50° field of view:
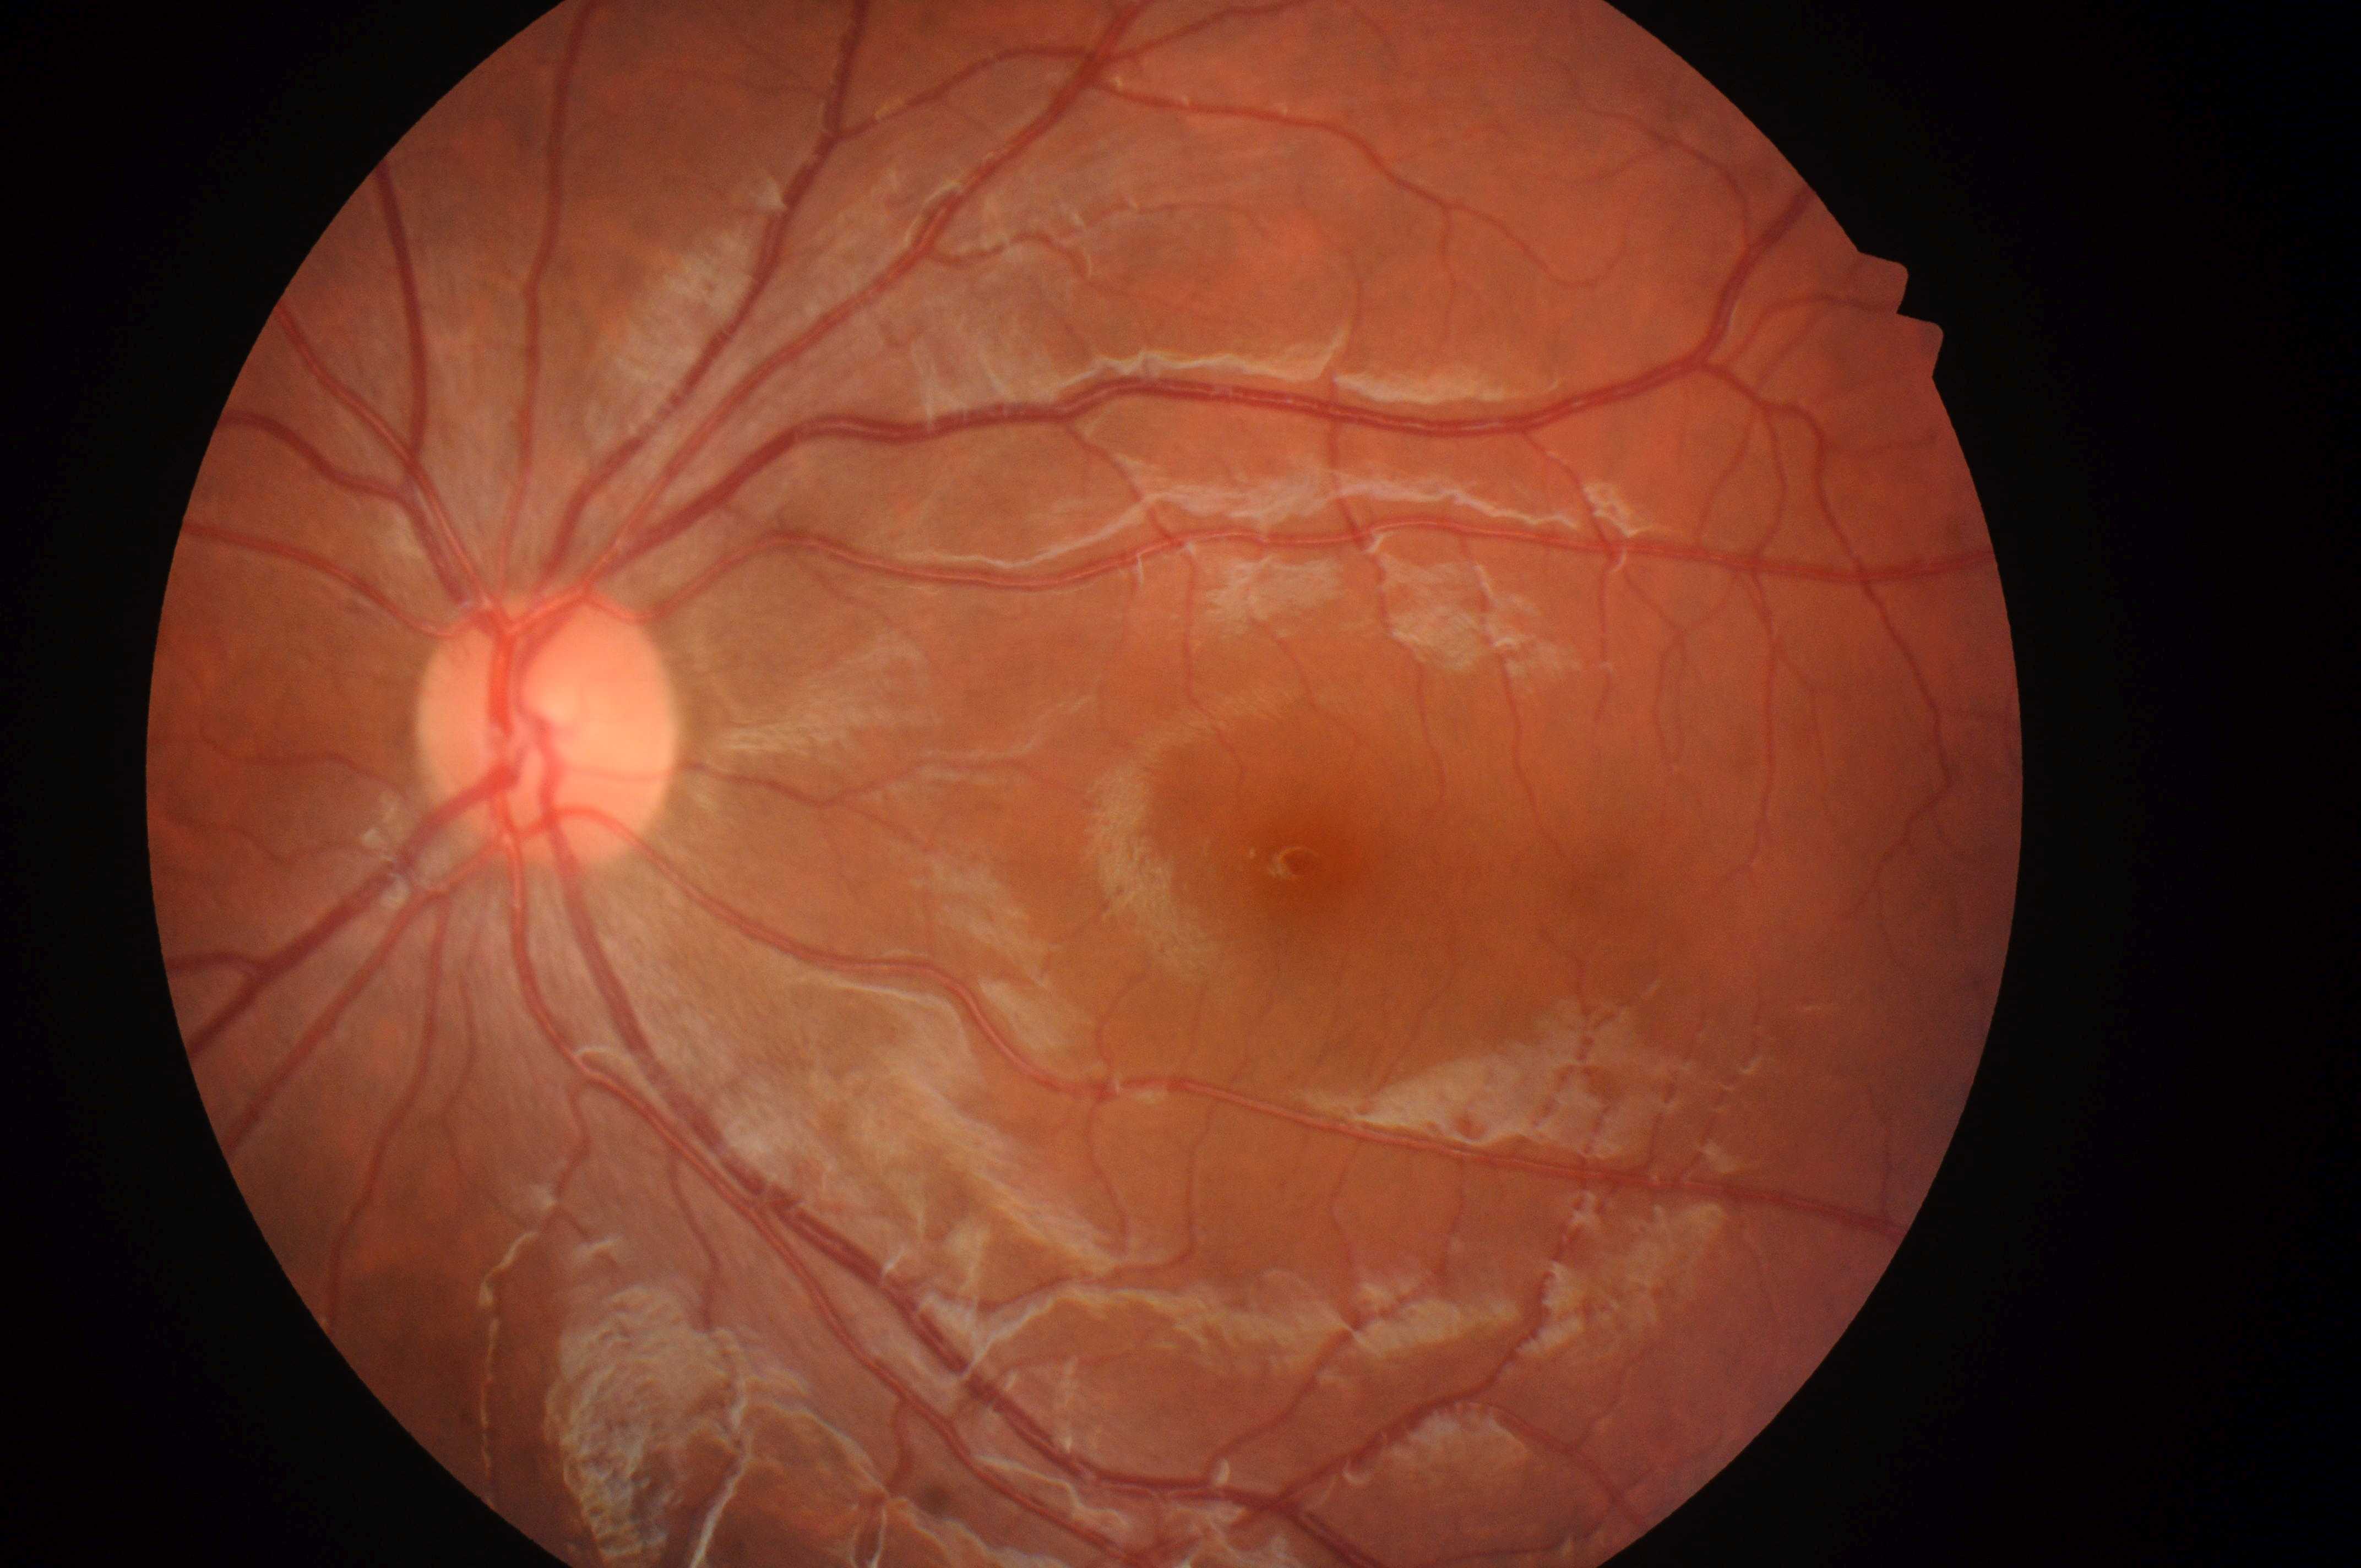 Optic nerve head: 540, 738. Risk of macular edema: 0/2. No signs of diabetic retinopathy or diabetic macular edema. Fovea: 1303, 864. Diabetic retinopathy grade: 0/4. The image shows the oculus sinister.